848 x 848 pixels · NIDEK AFC-230
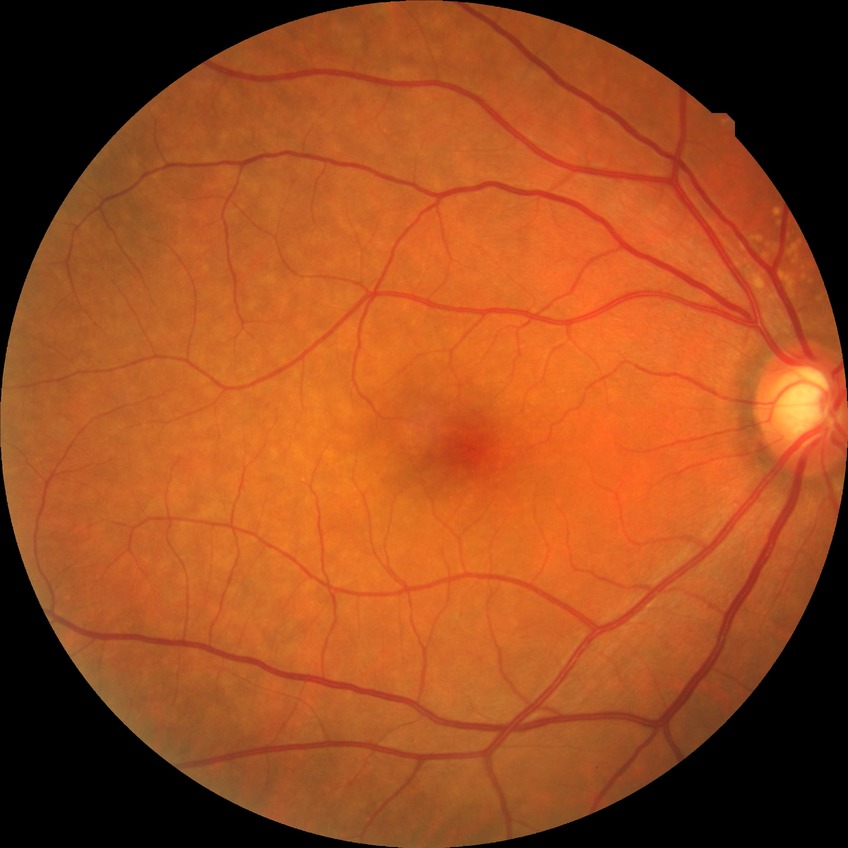
Diabetic retinopathy (DR) is NDR (no diabetic retinopathy).